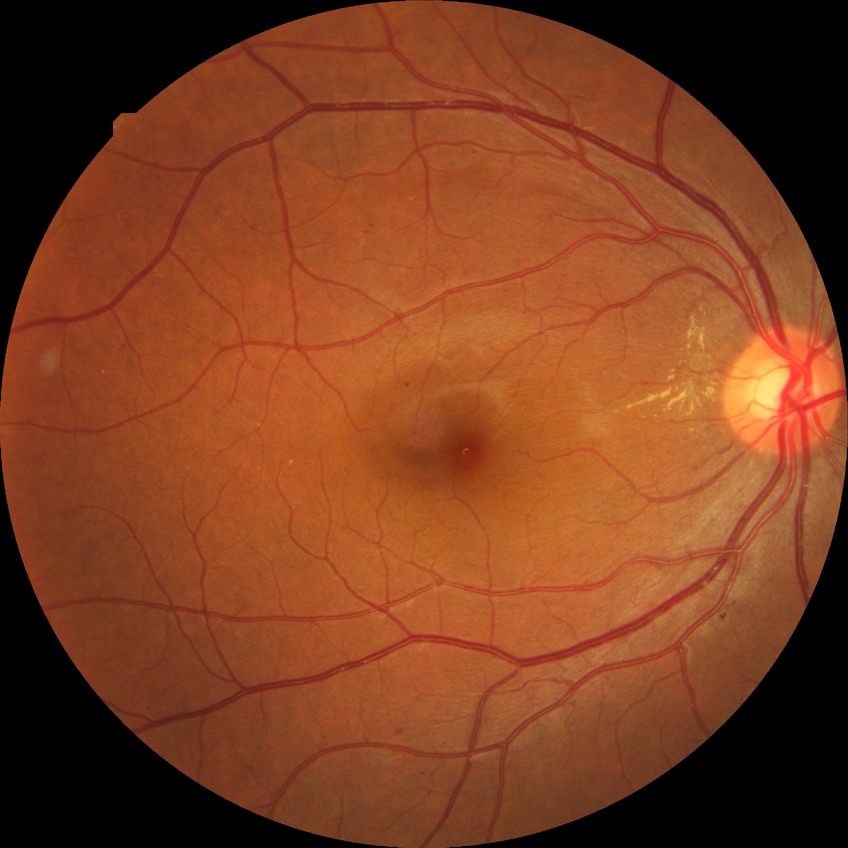

DR stage: SDR.